Natus RetCam Envision, 130° FOV · pediatric retinal photograph (wide-field) — 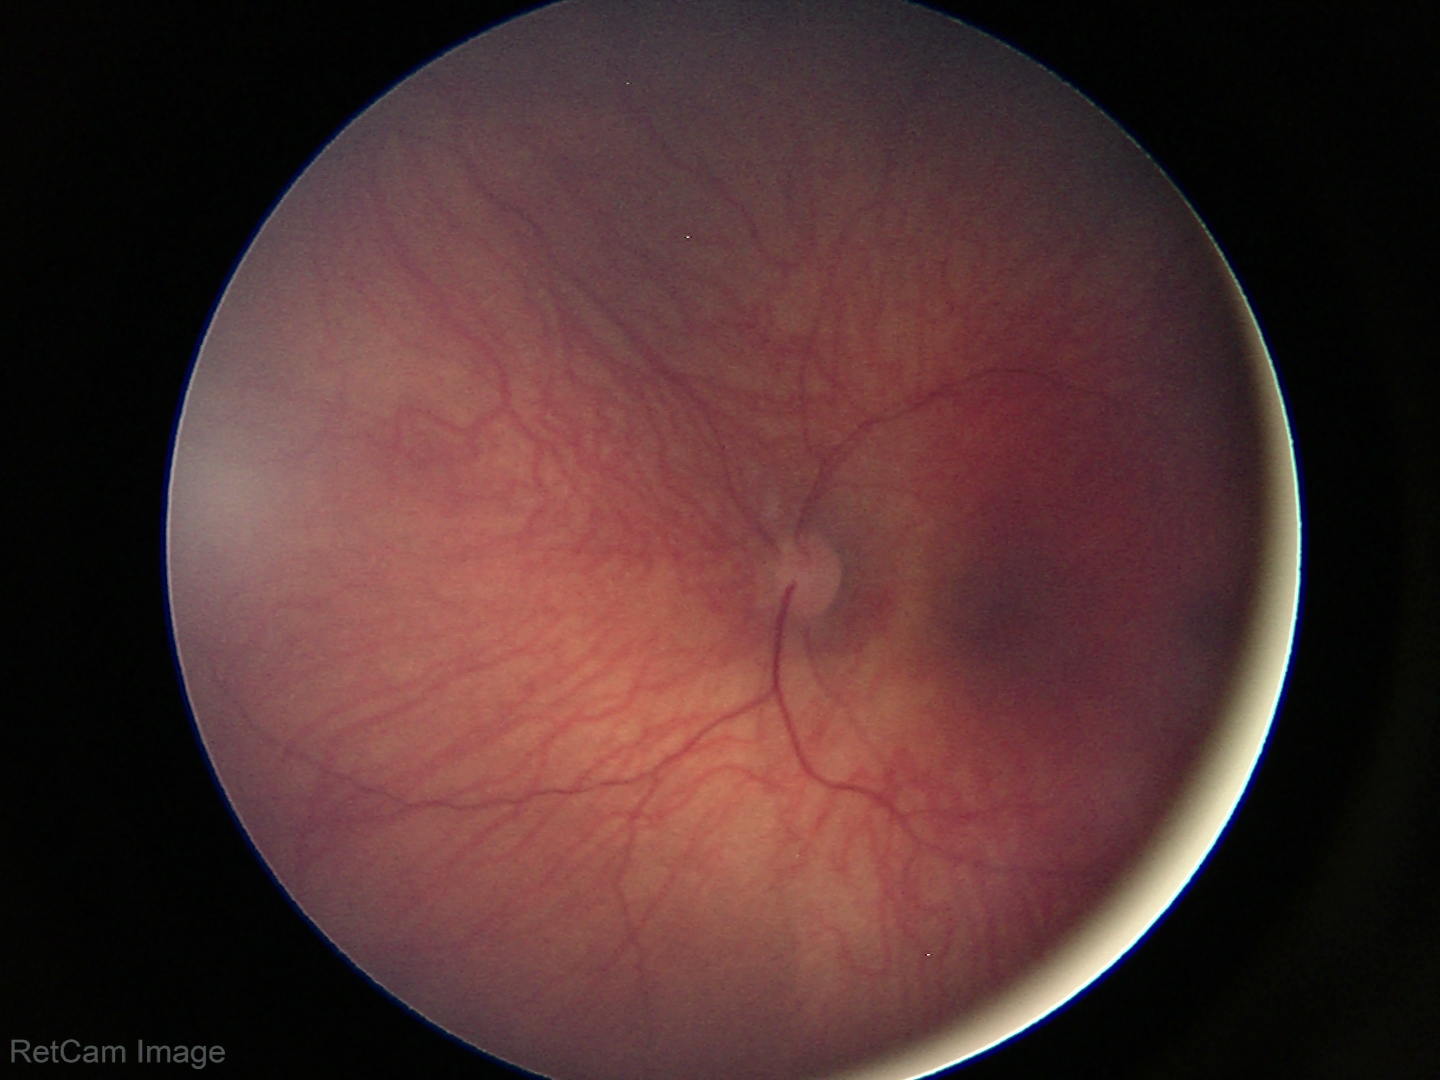
Assessment: normal retinal appearance.